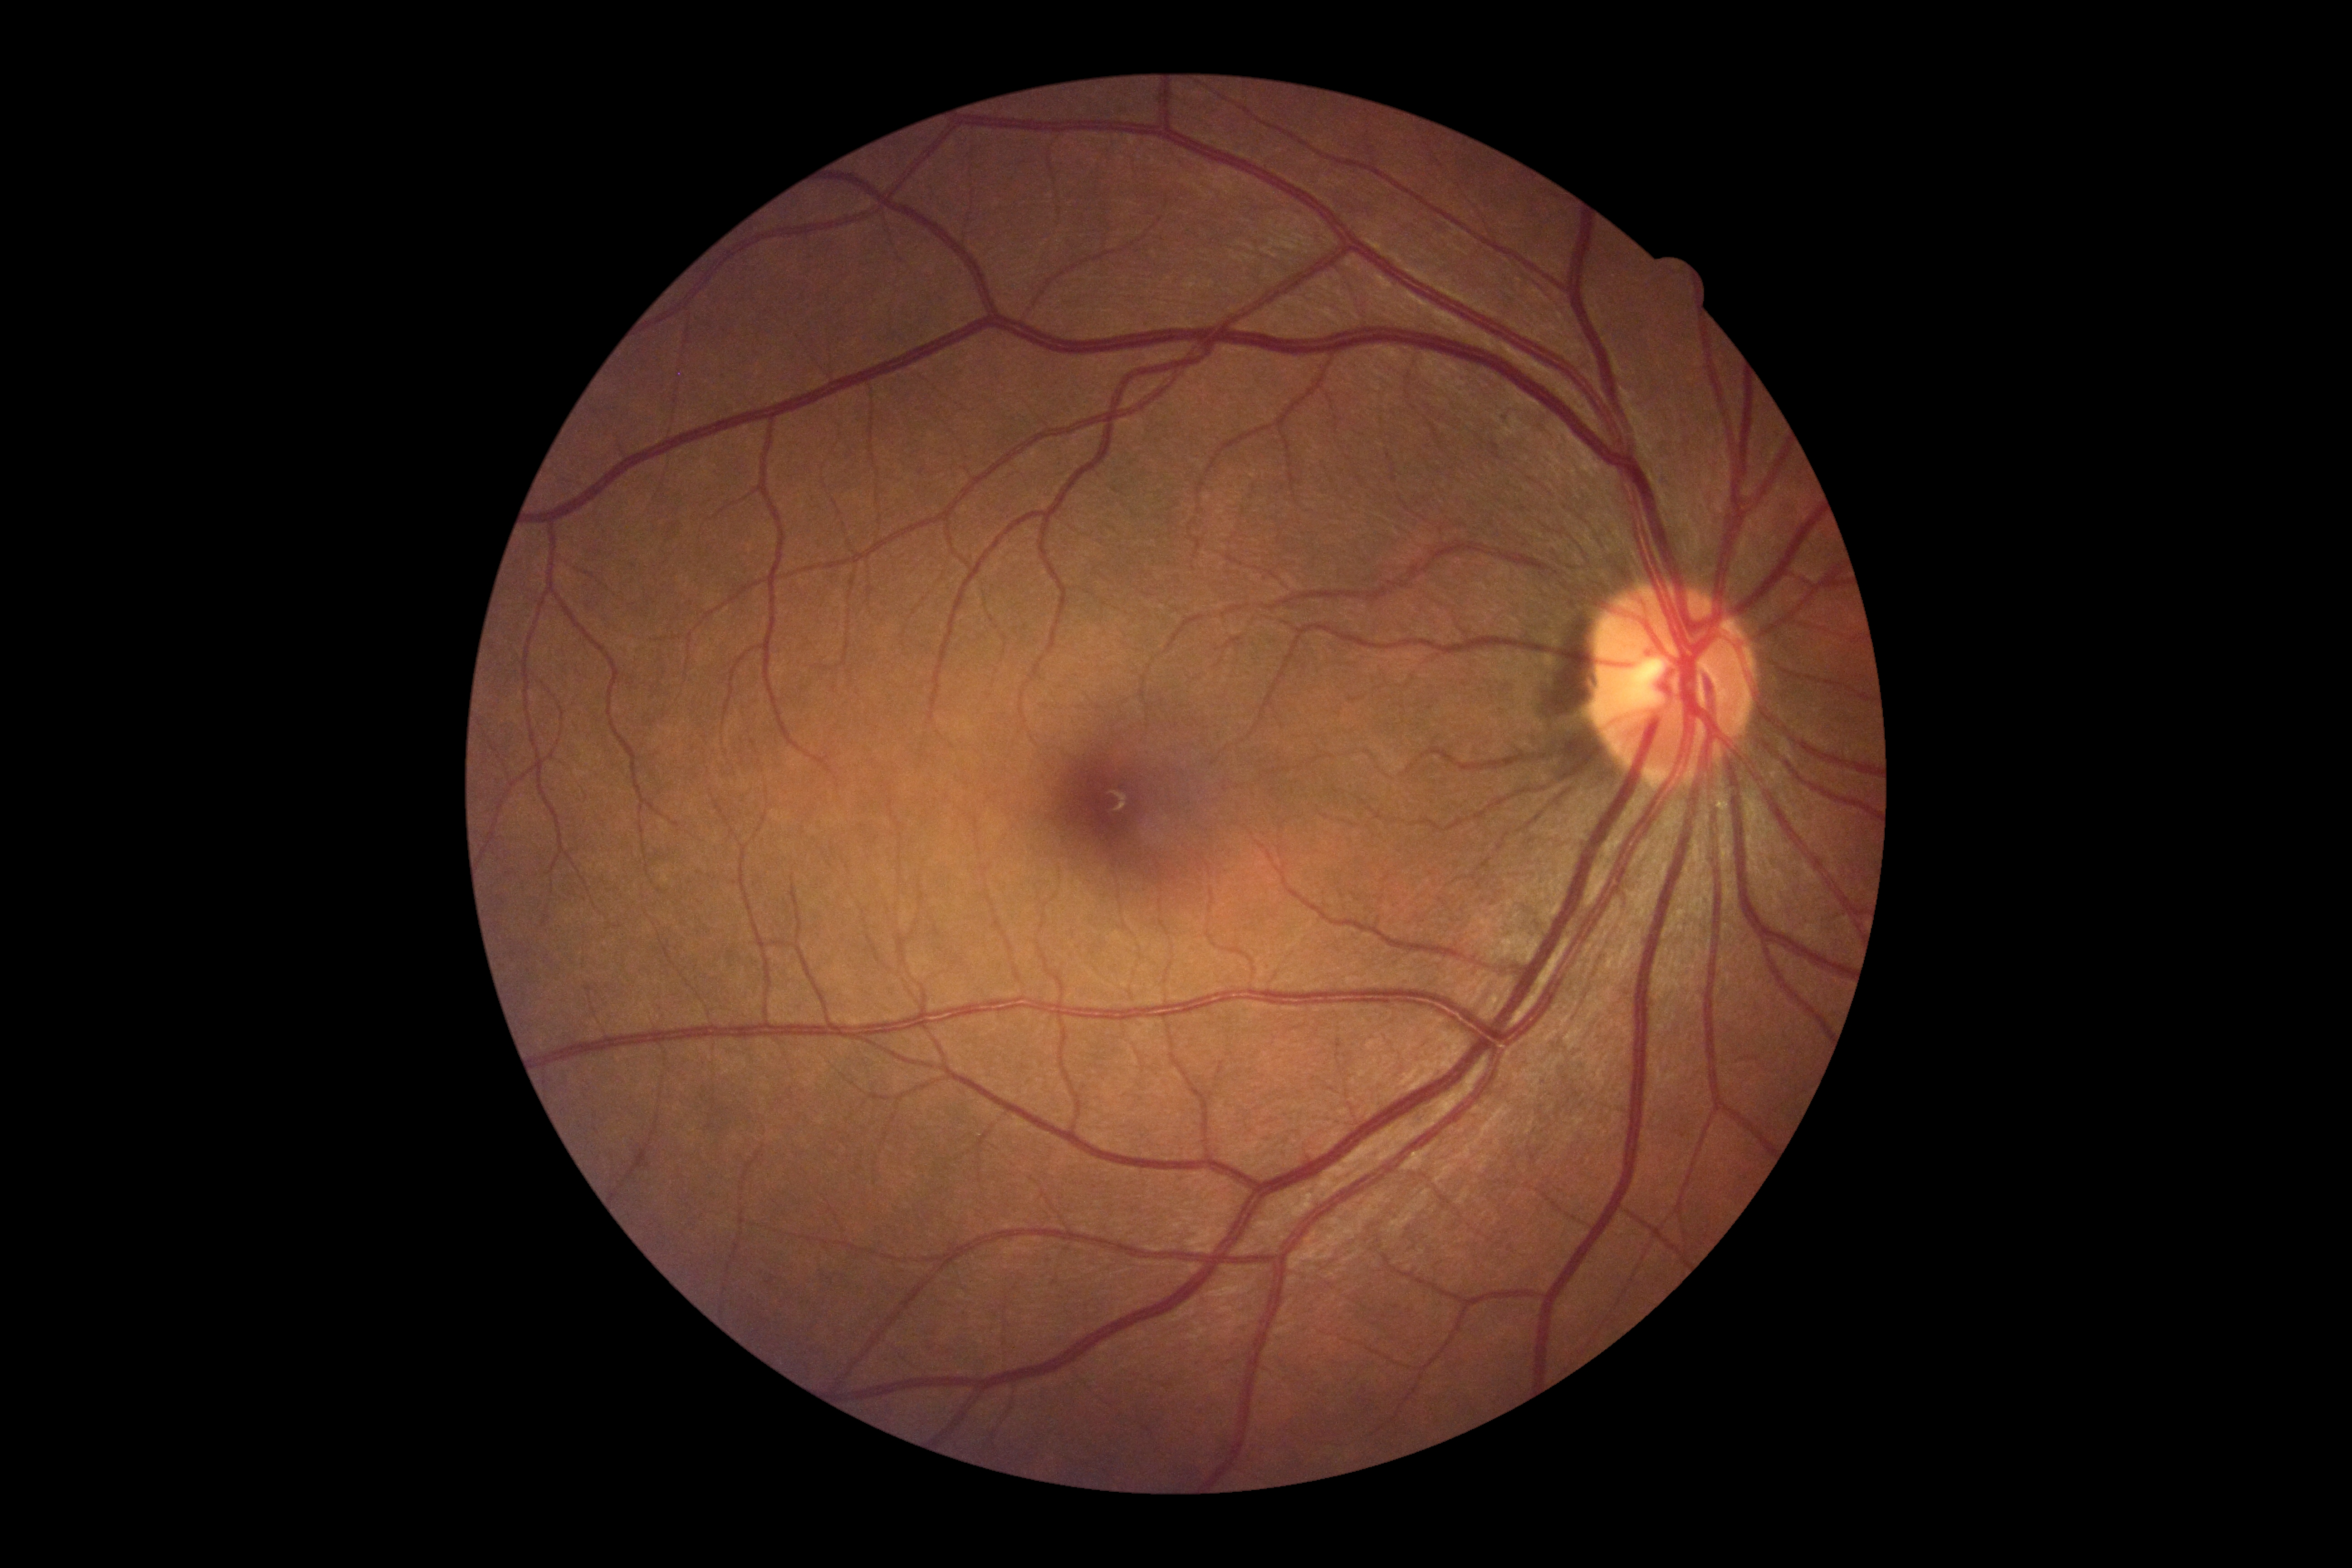

DR severity: grade 0 (no apparent retinopathy).